640x480px. Infant wide-field fundus photograph
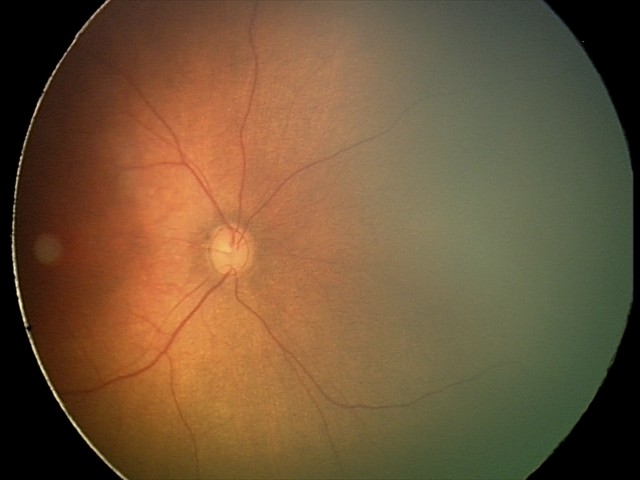 Q: What is the screening diagnosis?
A: physiological retinal finding